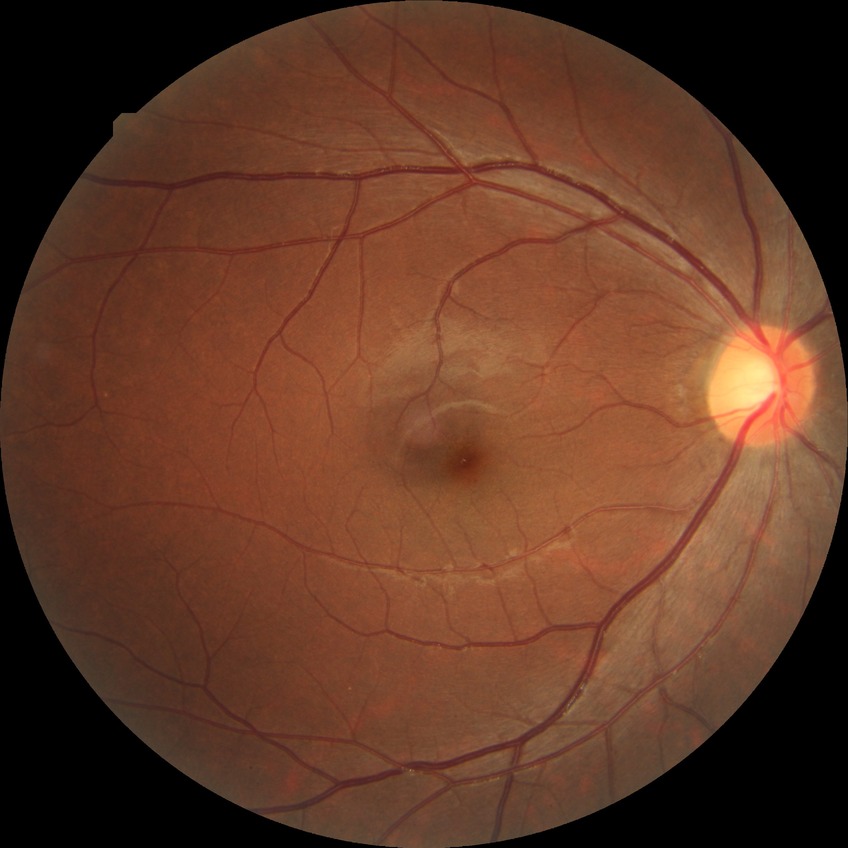 Annotations:
– diabetic retinopathy (DR) — no diabetic retinopathy (NDR)